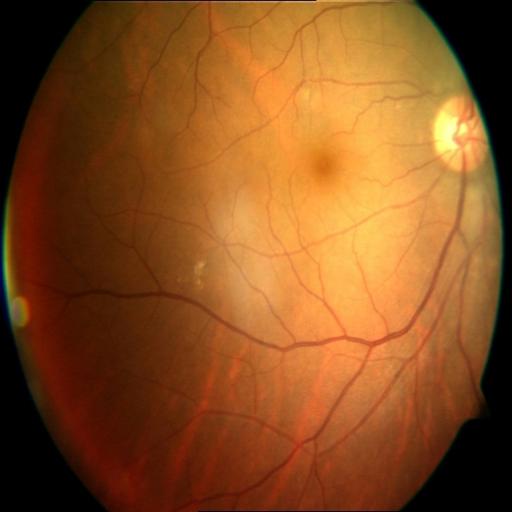

Diagnosis: CRS (chorioretinitis).